Diabetic retinopathy graded by the modified Davis classification, no pharmacologic dilation, 848x848px.
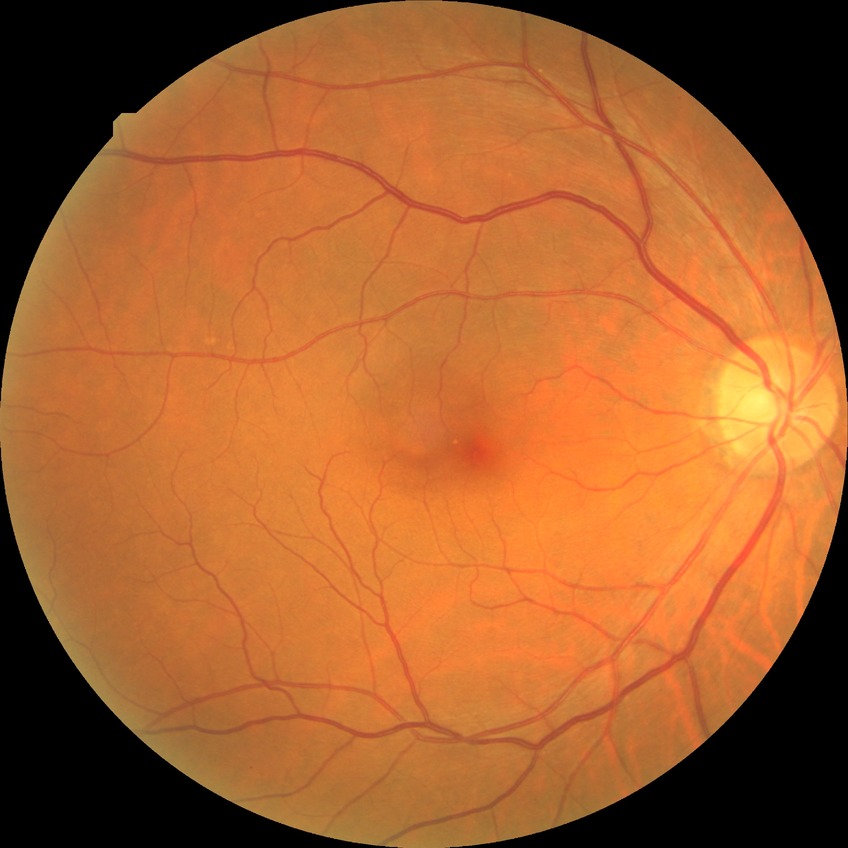 Diabetic retinopathy (DR): NDR (no diabetic retinopathy).